FOV: 45 degrees — 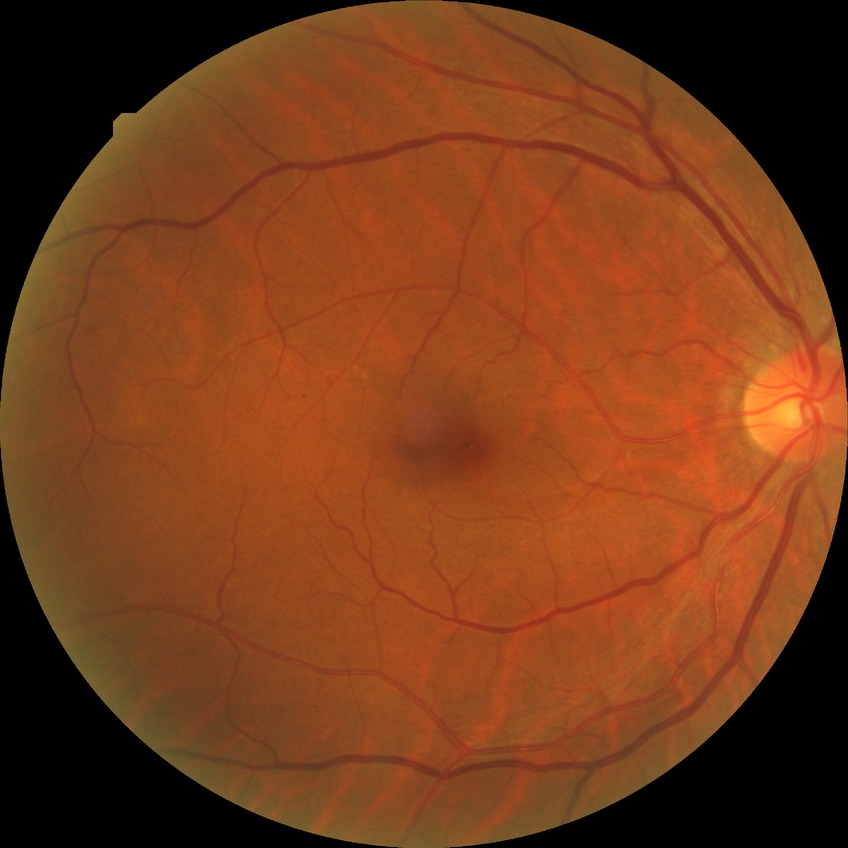
  davis_grade: simple diabetic retinopathy
  proliferative_class: non-proliferative diabetic retinopathy